Wide-field fundus photograph from neonatal ROP screening — 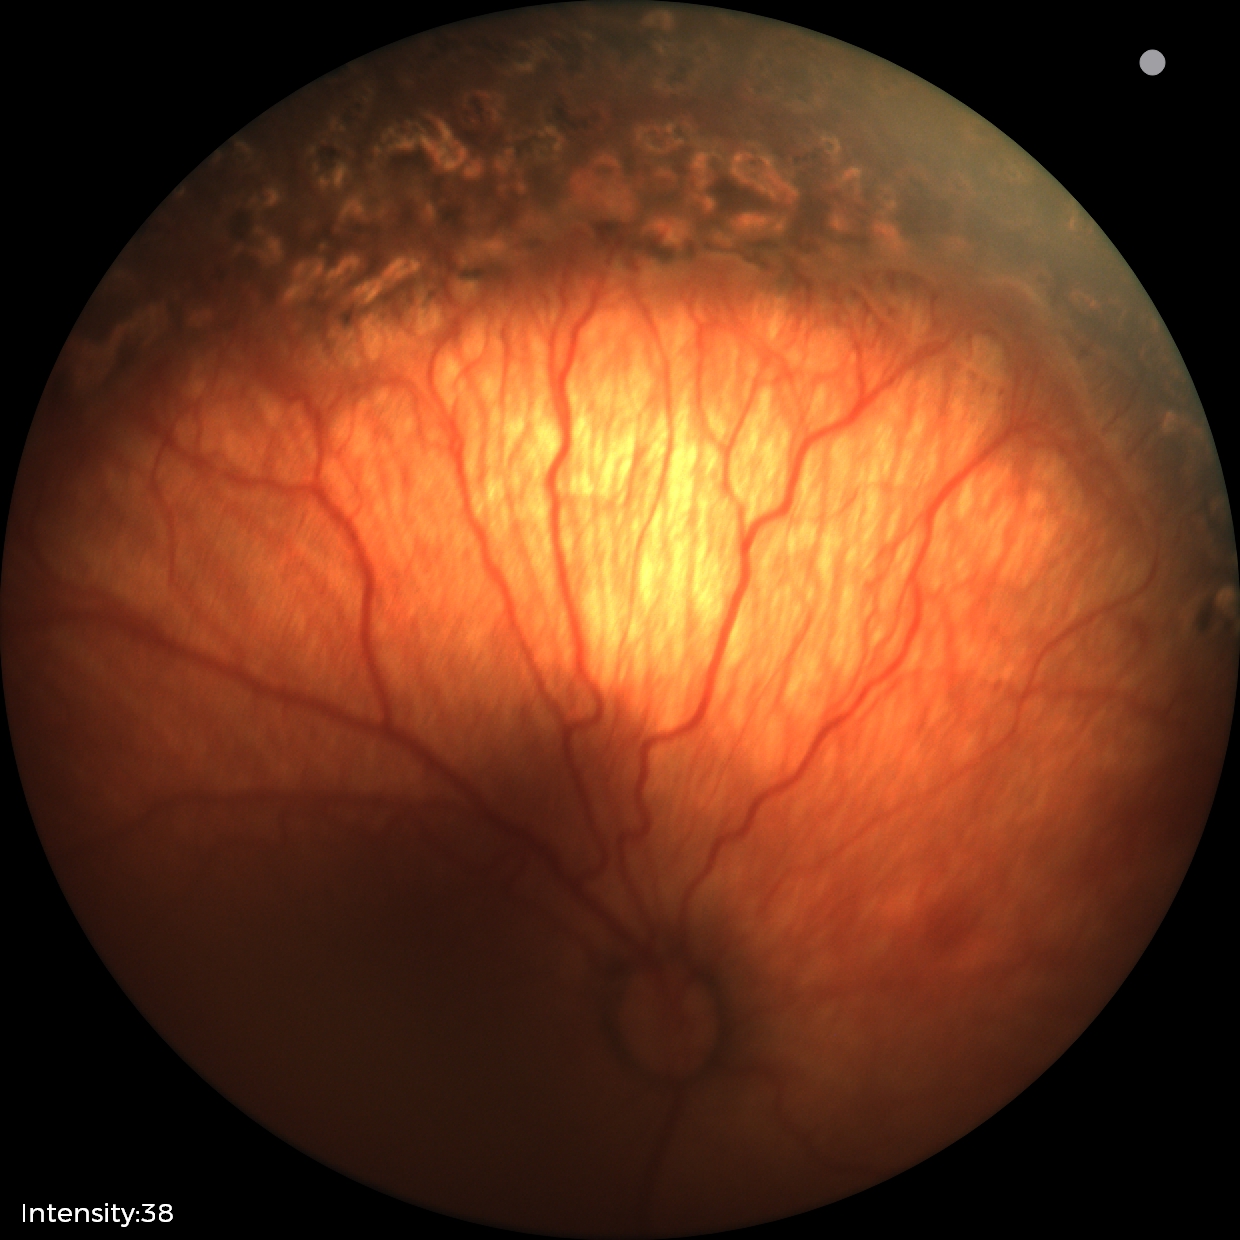 Without plus disease.
Screening examination consistent with status post retinopathy of prematurity.